Acquired with a NIDEK AFC-230 · retinal fundus photograph · image size 848x848 — 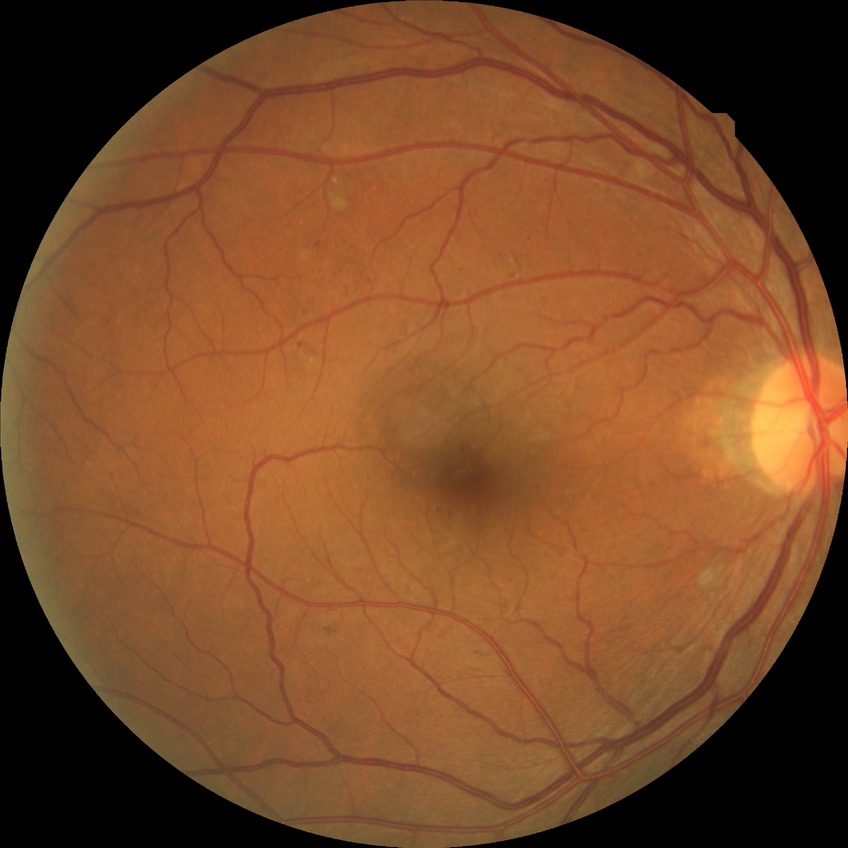

diabetic retinopathy (DR) = SDR (simple diabetic retinopathy).